1932x1932px — 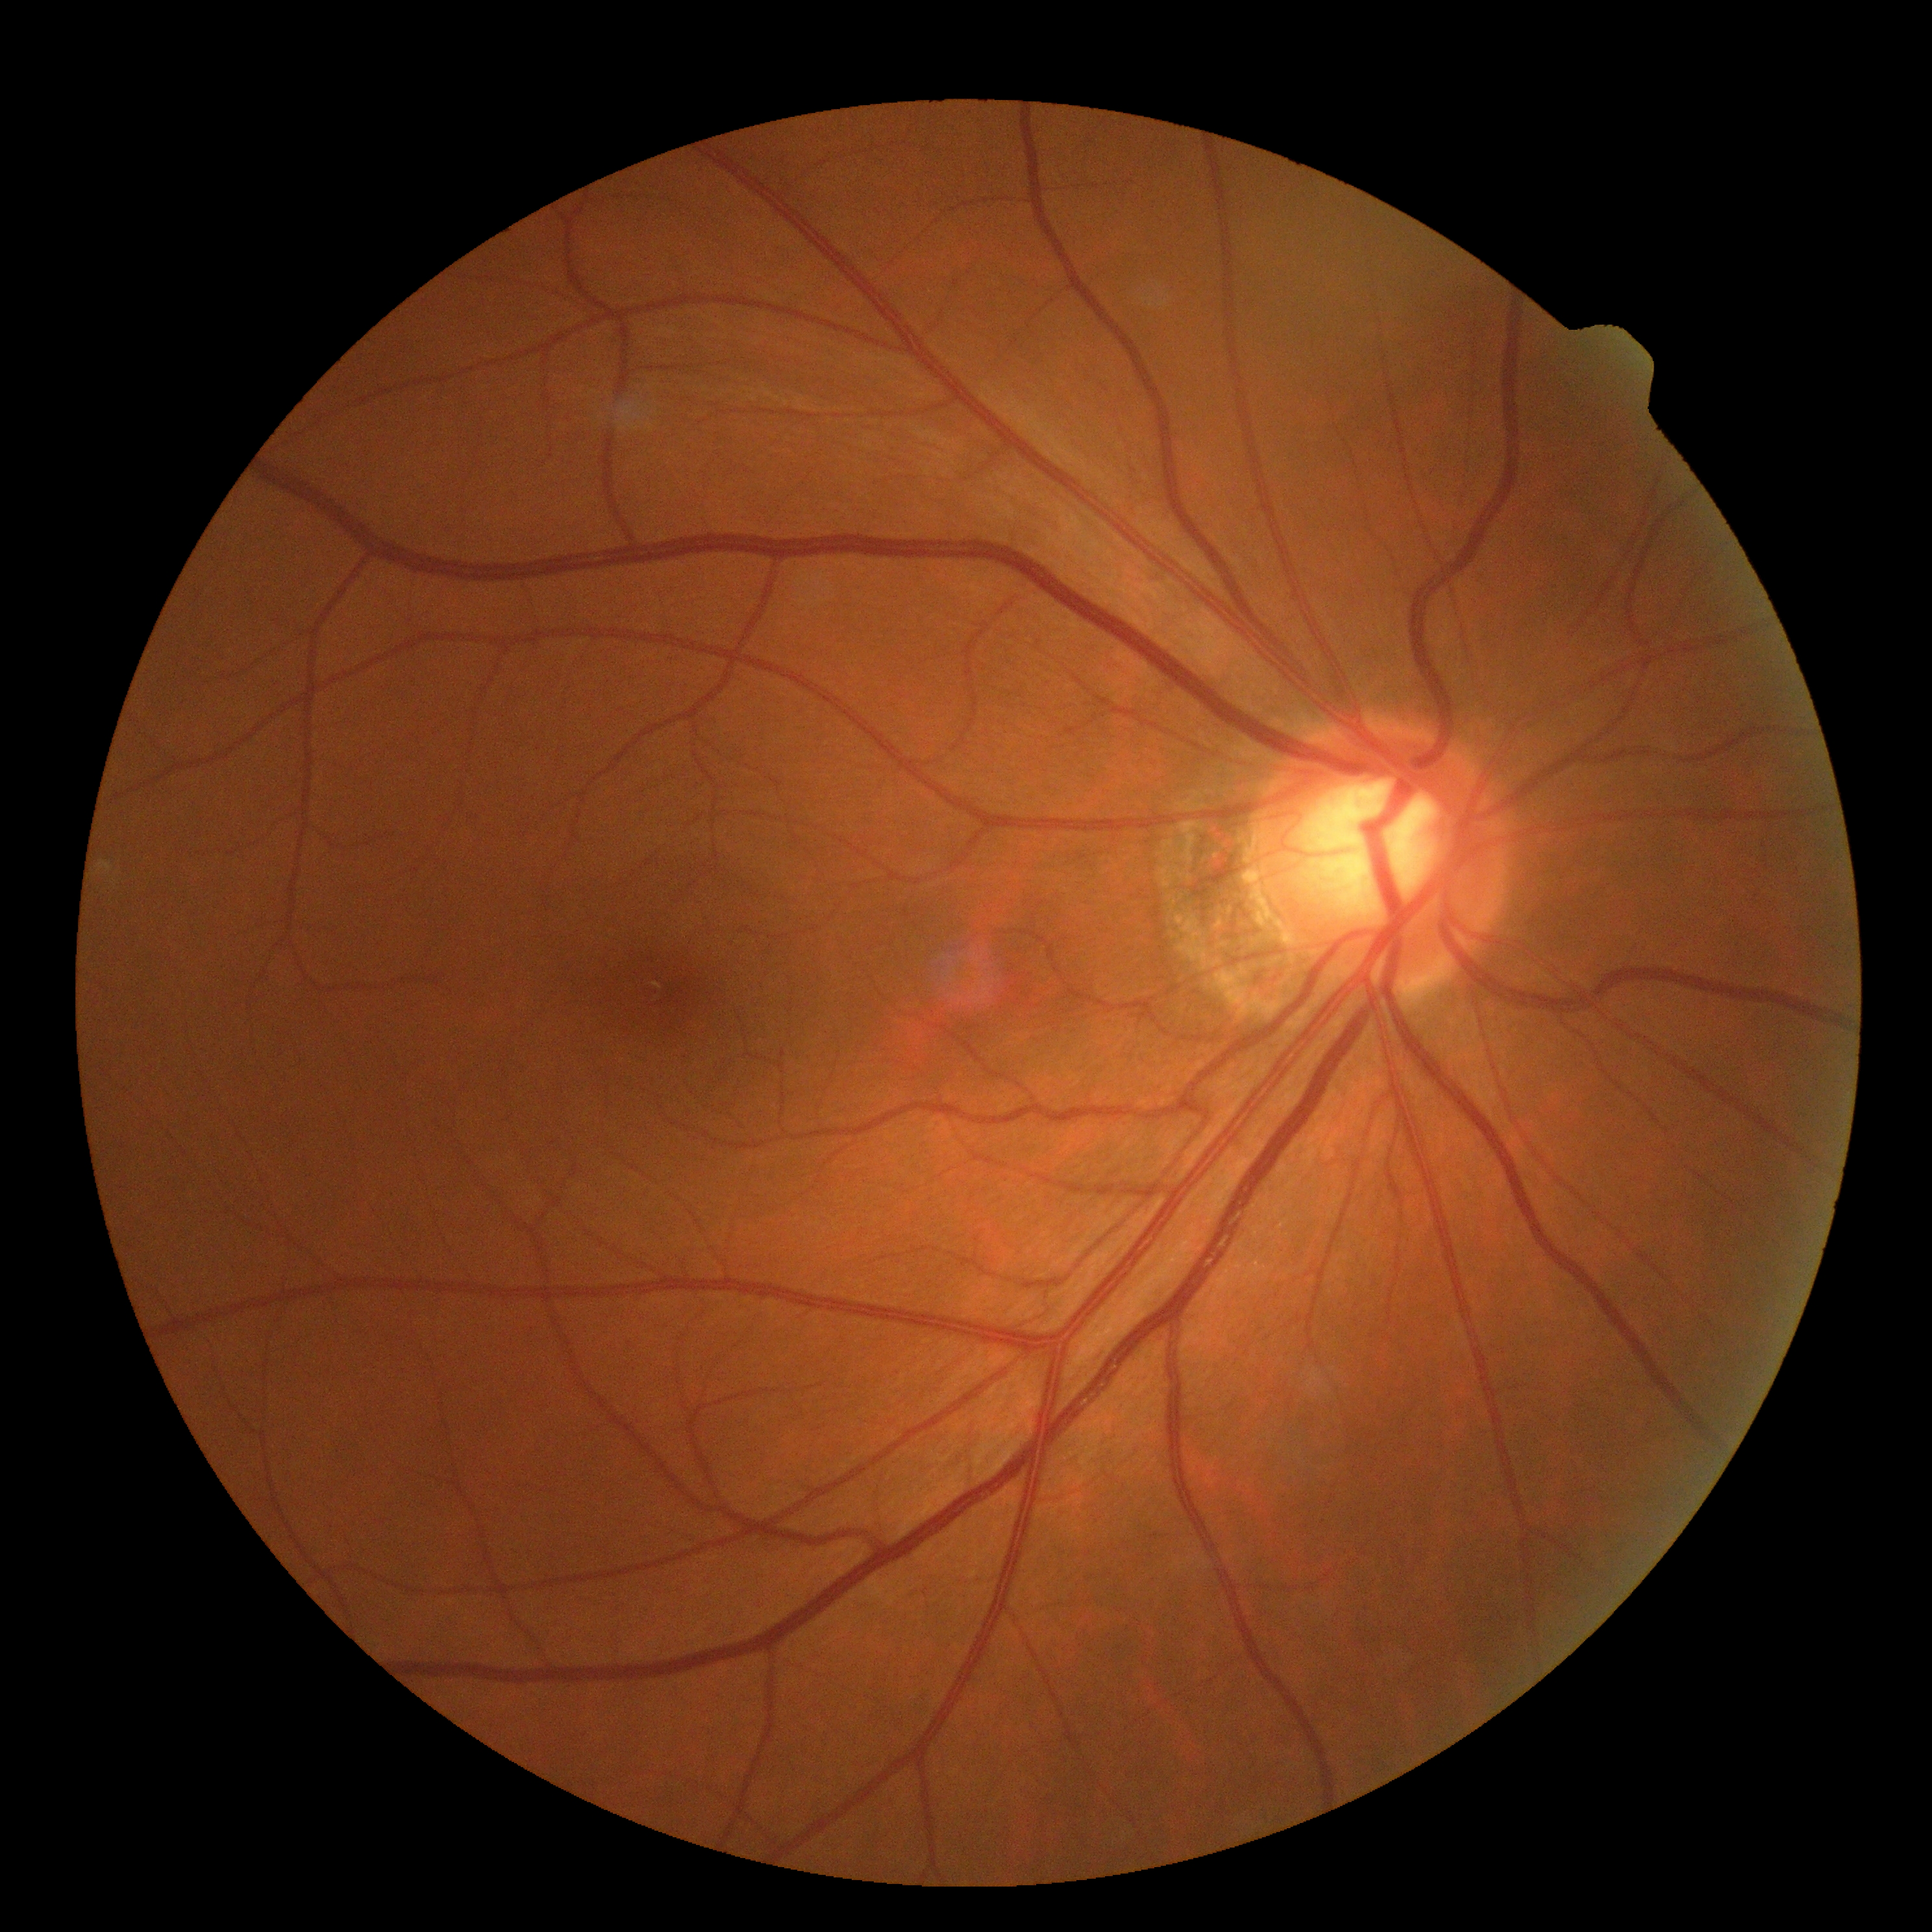

DR is grade 0.